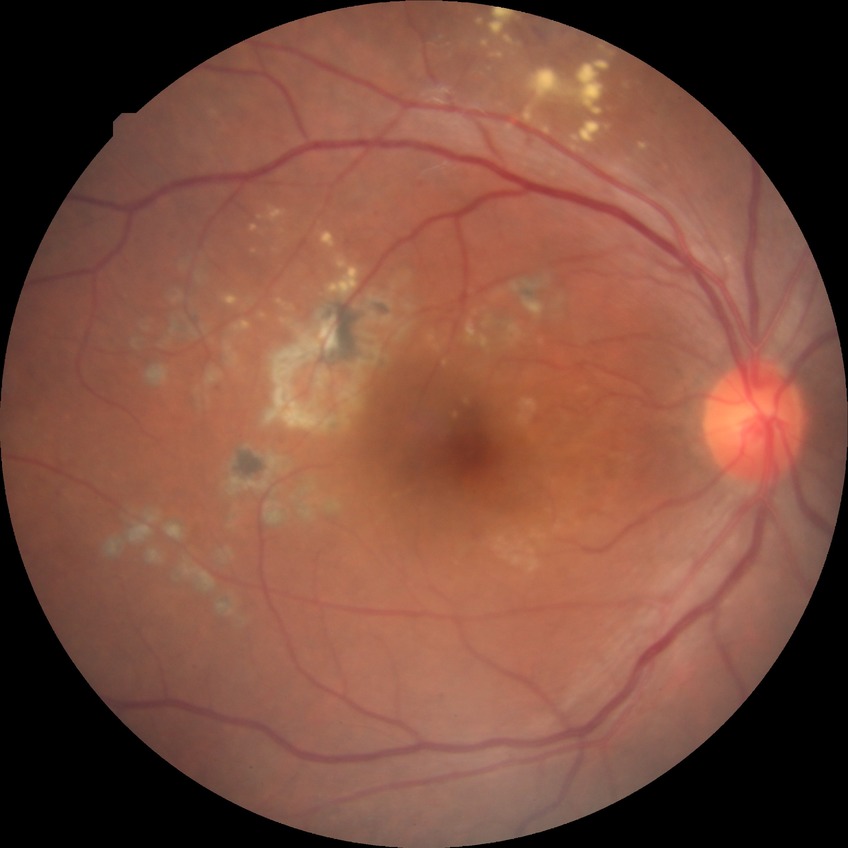
The retinopathy is classified as non-proliferative diabetic retinopathy. Diabetic retinopathy grade is simple diabetic retinopathy.